Davis DR grading
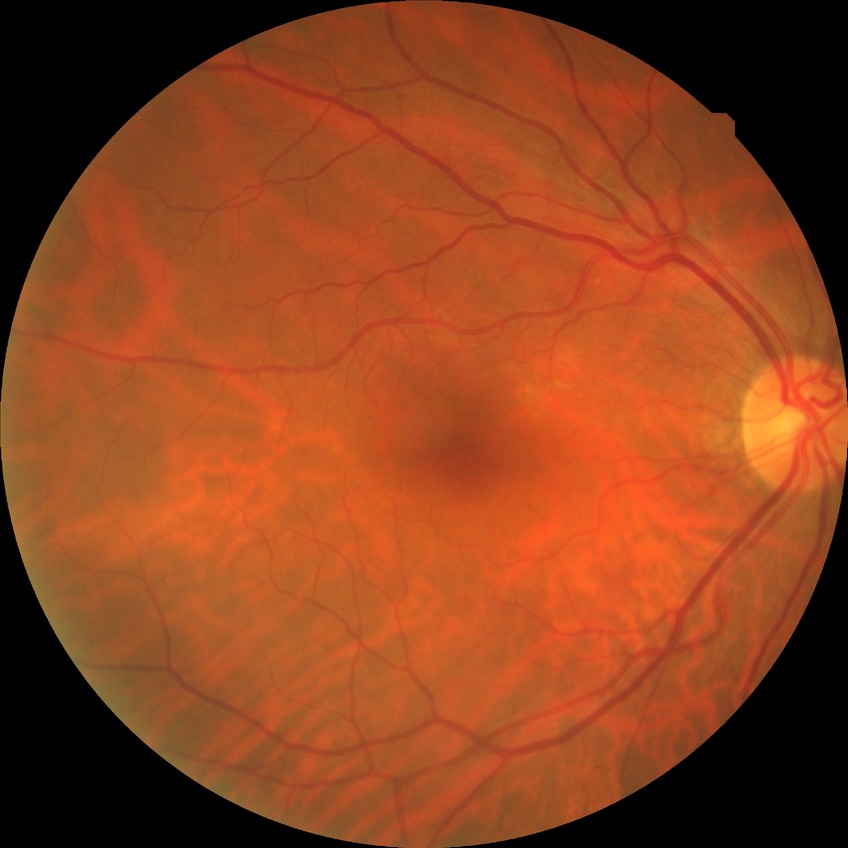 diabetic retinopathy (DR) = NDR (no diabetic retinopathy).